FOV: 45 degrees; fundus photo; without pupil dilation; acquired with a NIDEK AFC-230; graded on the modified Davis scale.
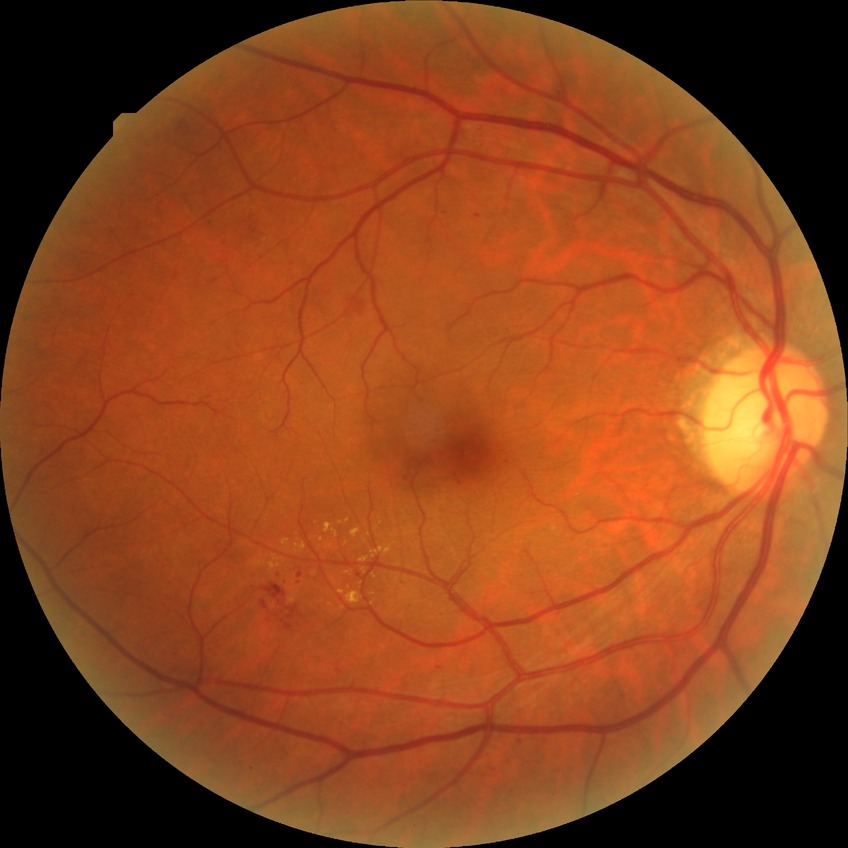 Diabetic retinopathy (DR): SDR (simple diabetic retinopathy).